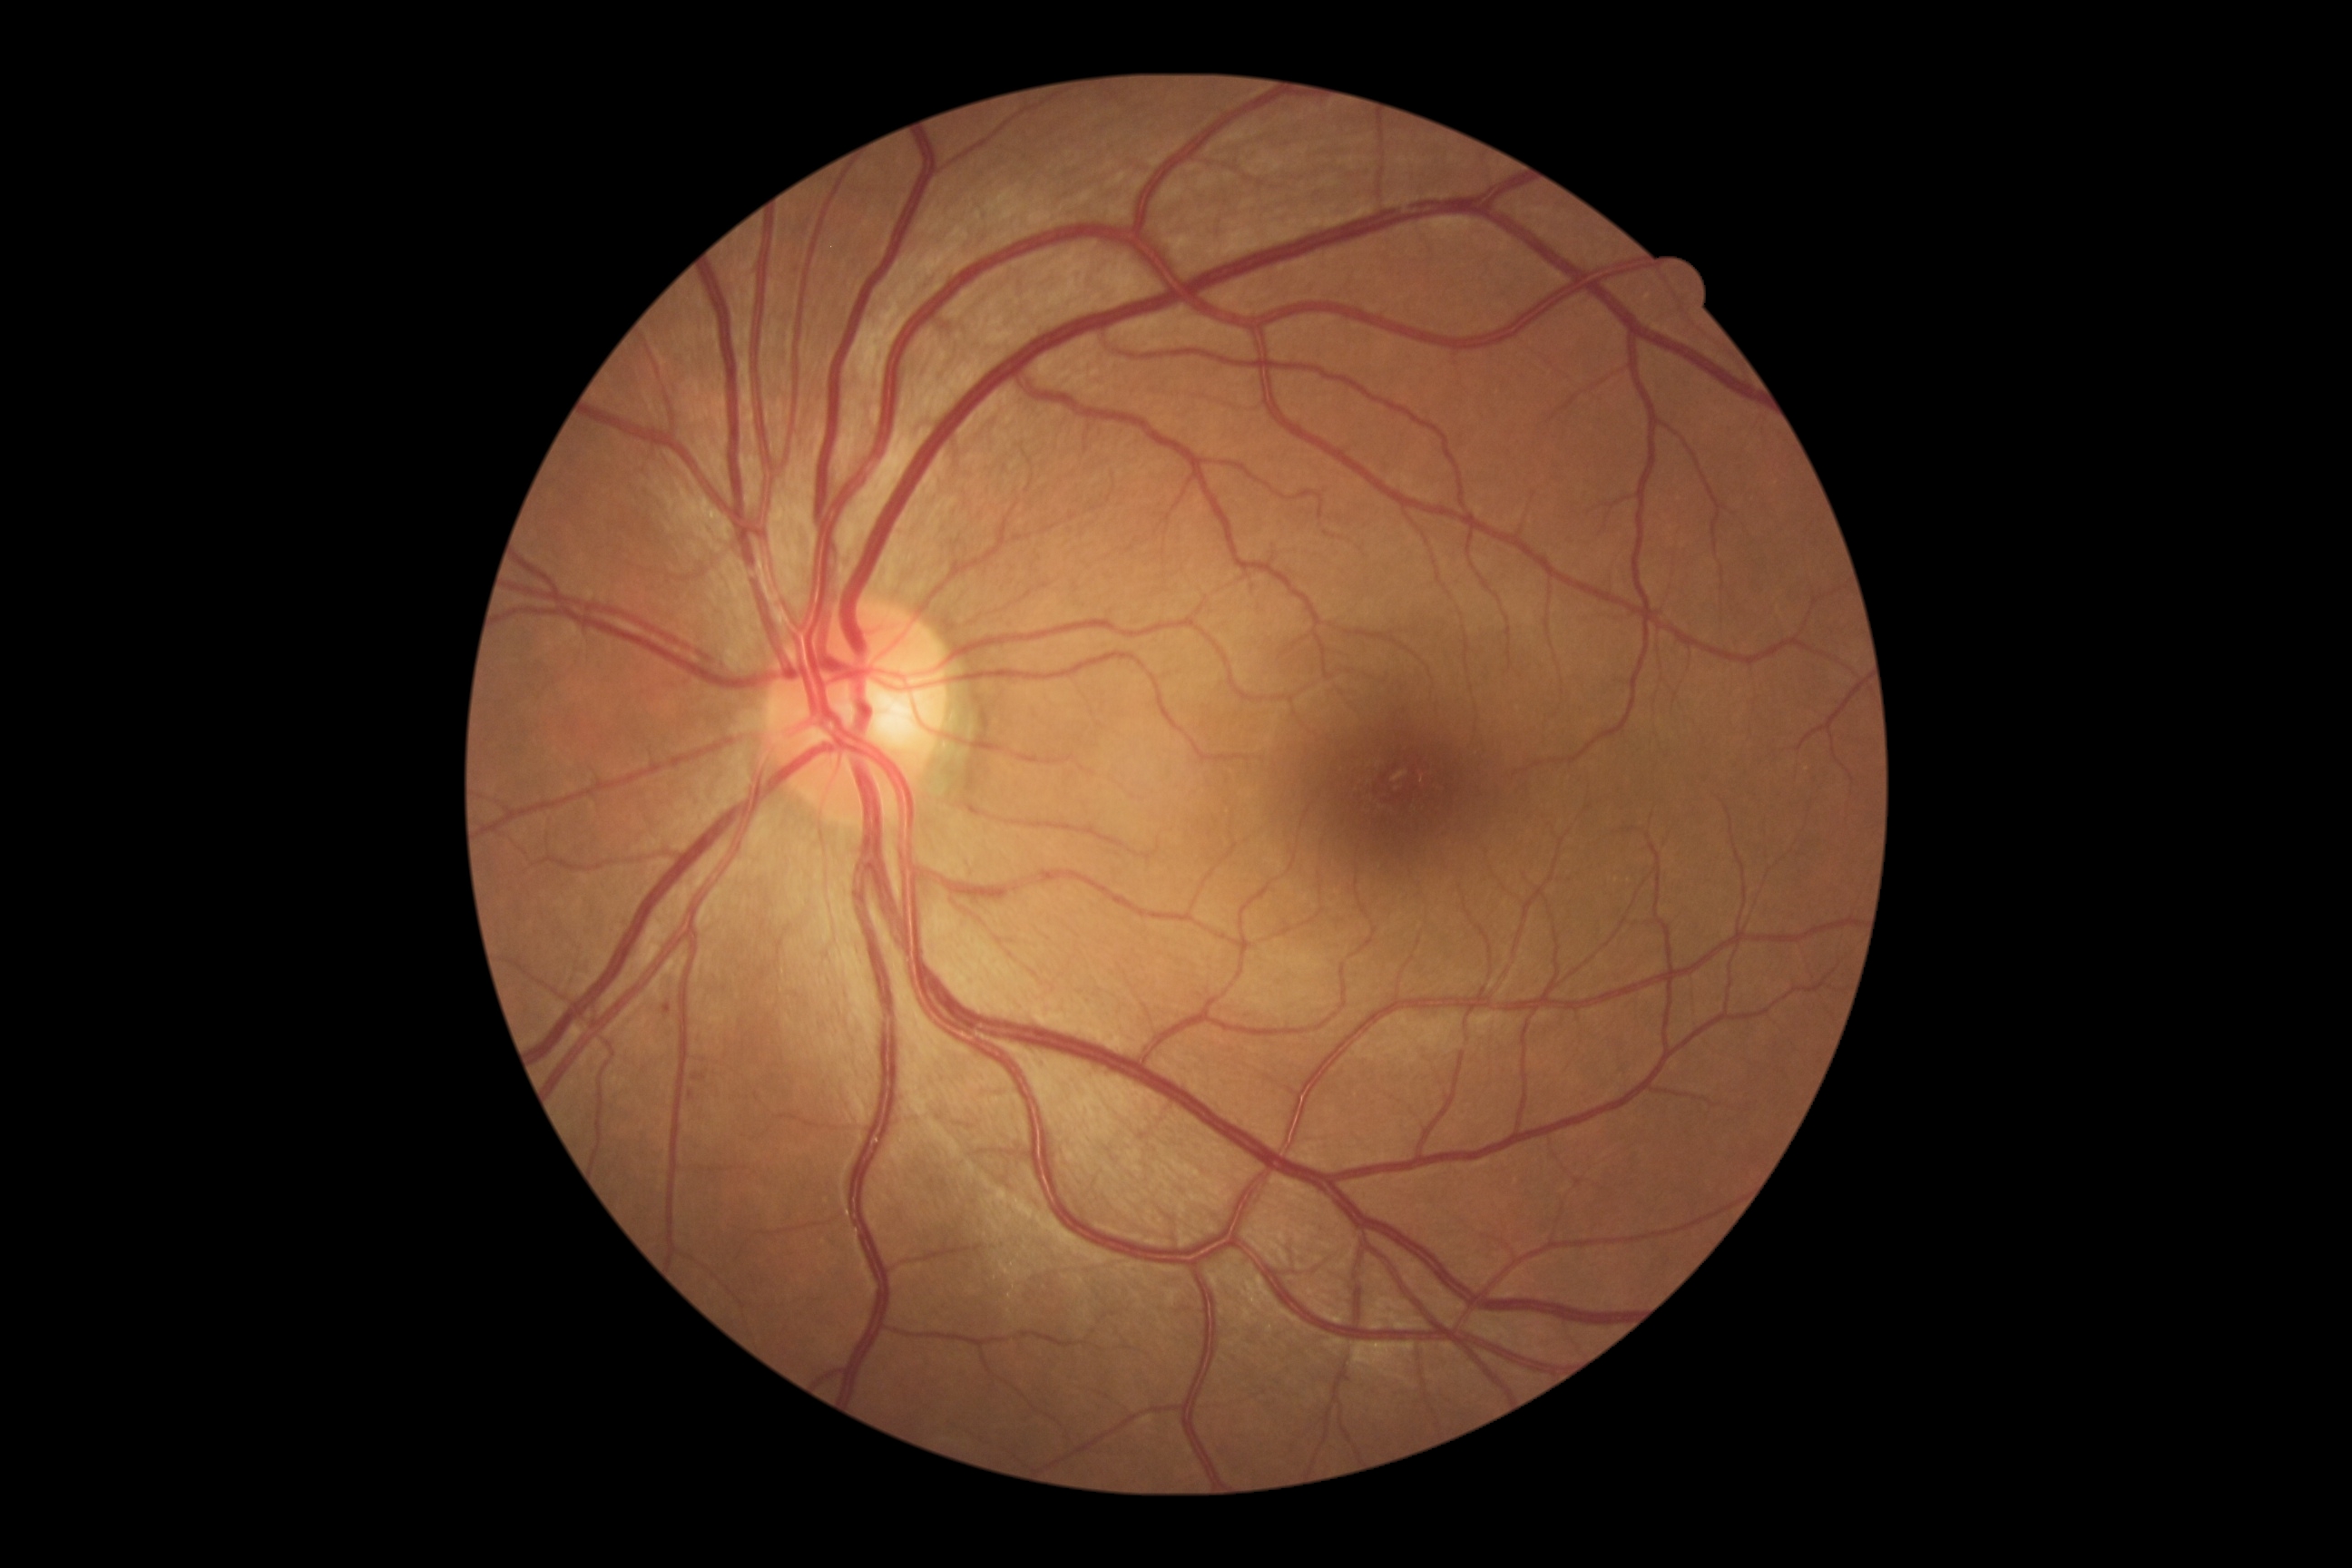

DR stage: mild non-proliferative diabetic retinopathy (grade 1) — presence of microaneurysms only.
Disease class: non-proliferative diabetic retinopathy.